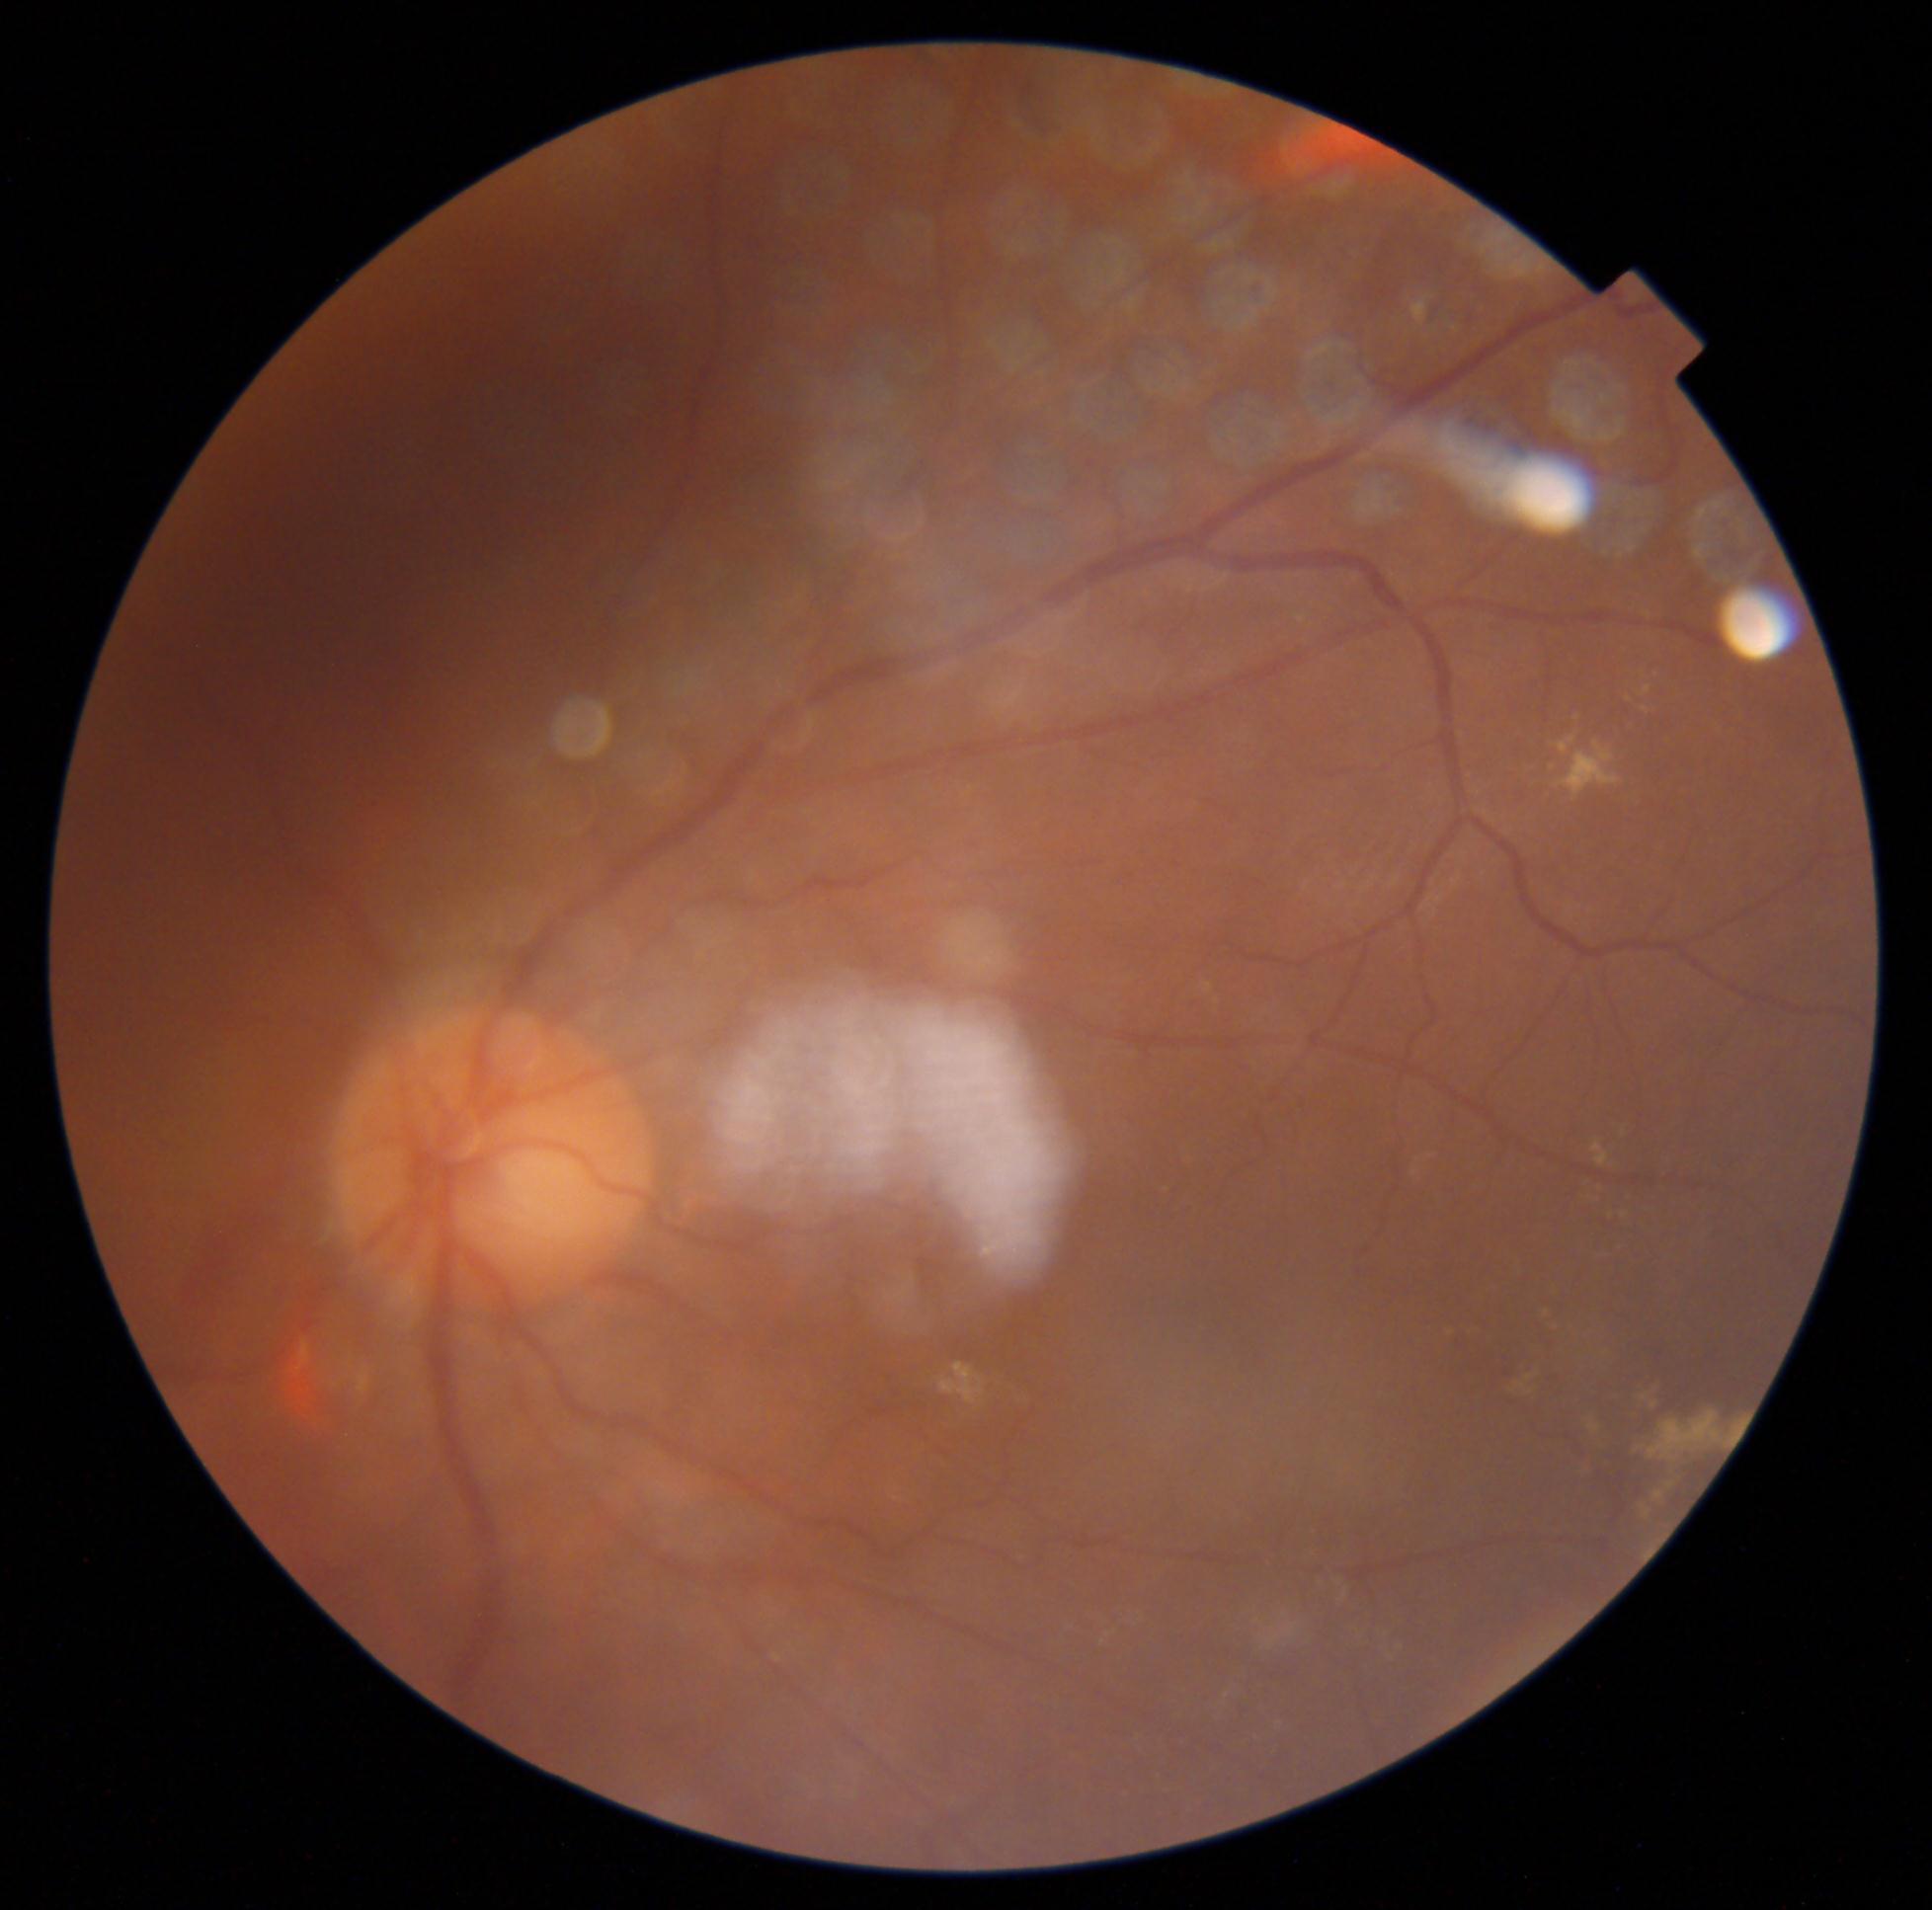

Disease class: non-proliferative diabetic retinopathy. DR severity is grade 2.